Optic disc-centered crop:
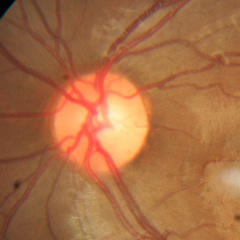 Glaucoma diagnosis: no glaucomatous findings.